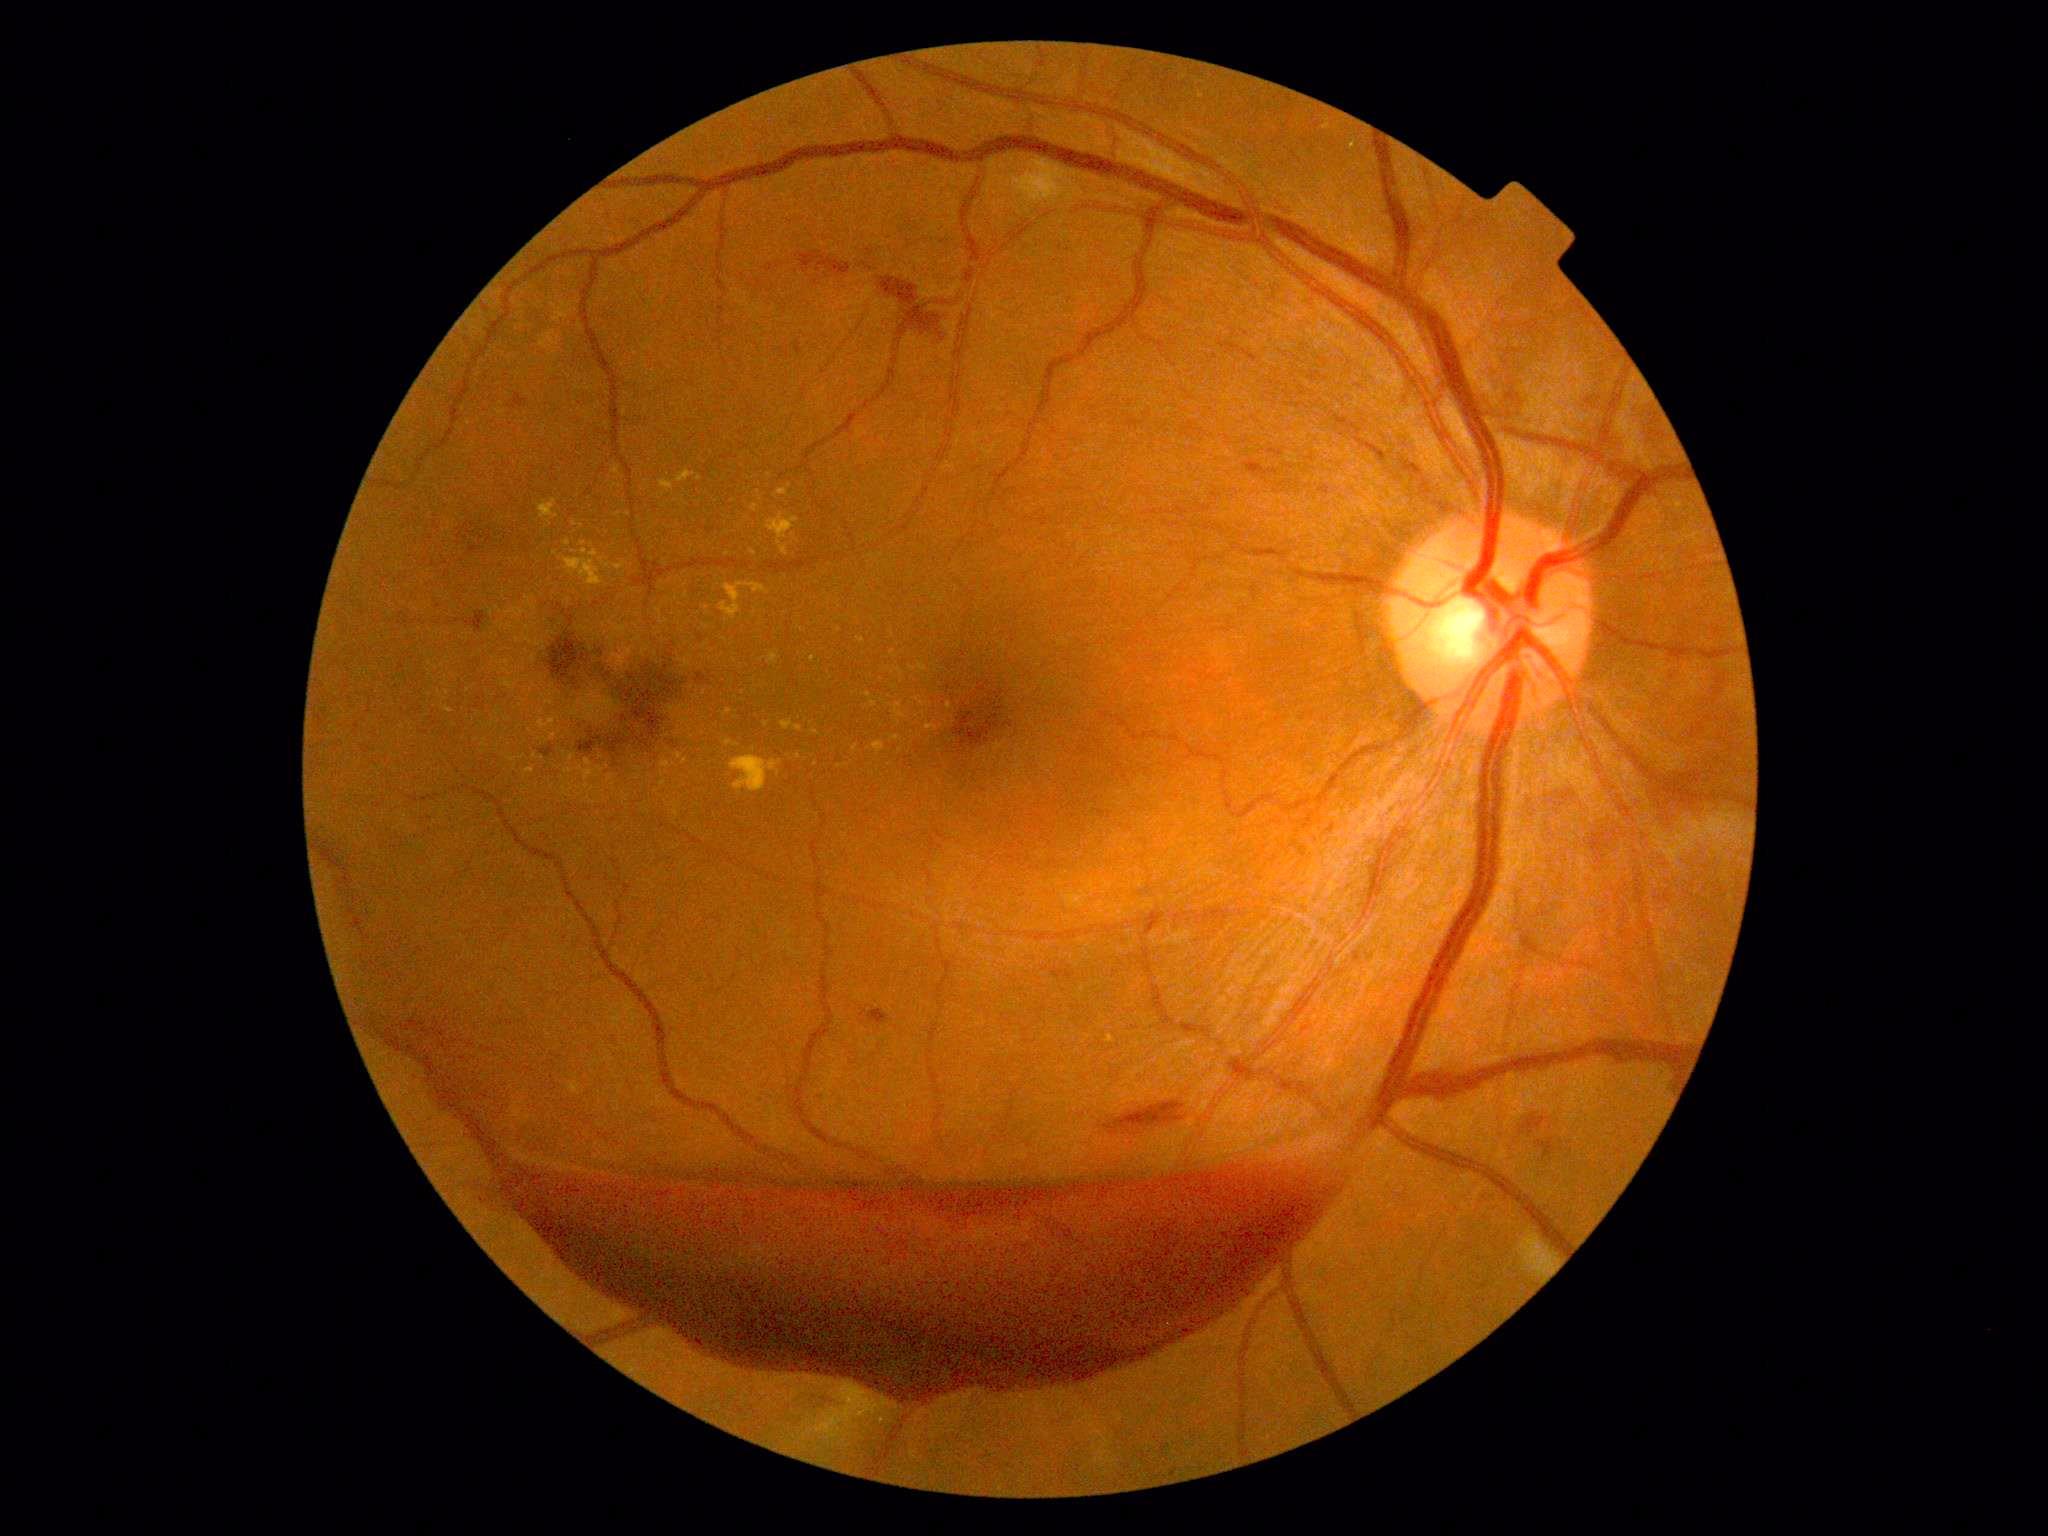 Diabetic retinopathy grade is 4
A subset of detected lesions:
hard exudates (continued): 857:637:865:643; 946:703:953:711; 676:471:696:483; 613:562:627:570; 768:651:781:664; 766:513:800:556; 811:729:821:737; 444:707:454:714
Smaller hard exudates around (582; 527); (893; 634); (727; 533); (629; 515); (564; 754); (890; 705); (767; 724); (429; 695); (812; 659); (678; 579)